Modified Davis grading — 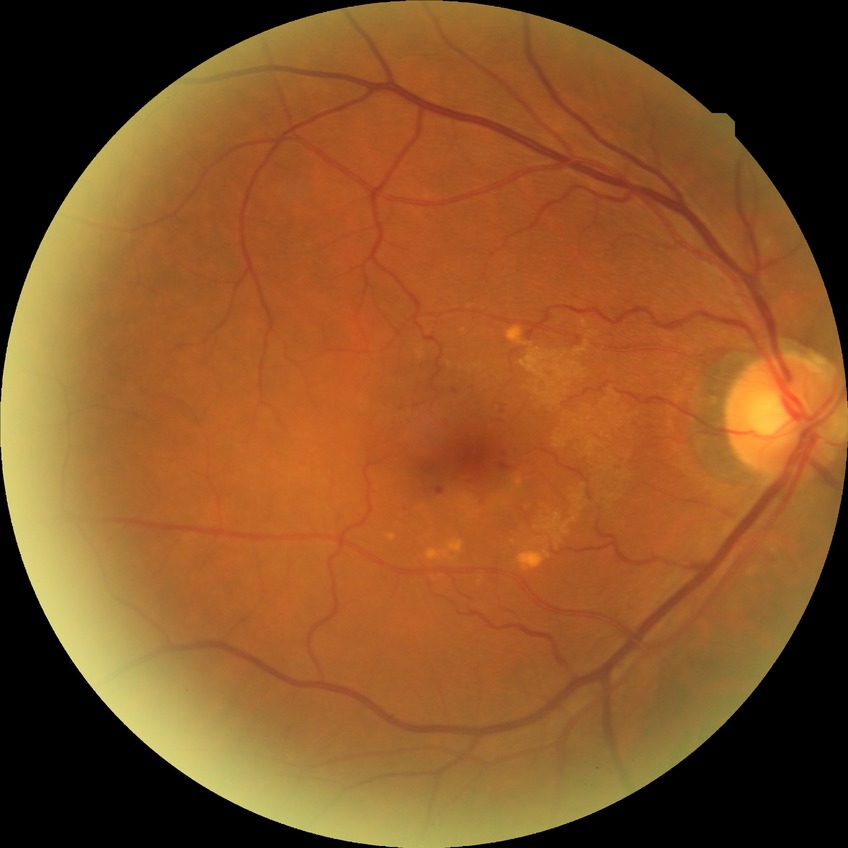
Diabetic retinopathy (DR): simple diabetic retinopathy (SDR).